2361 x 1568 pixels, CFP, FOV: 50 degrees:
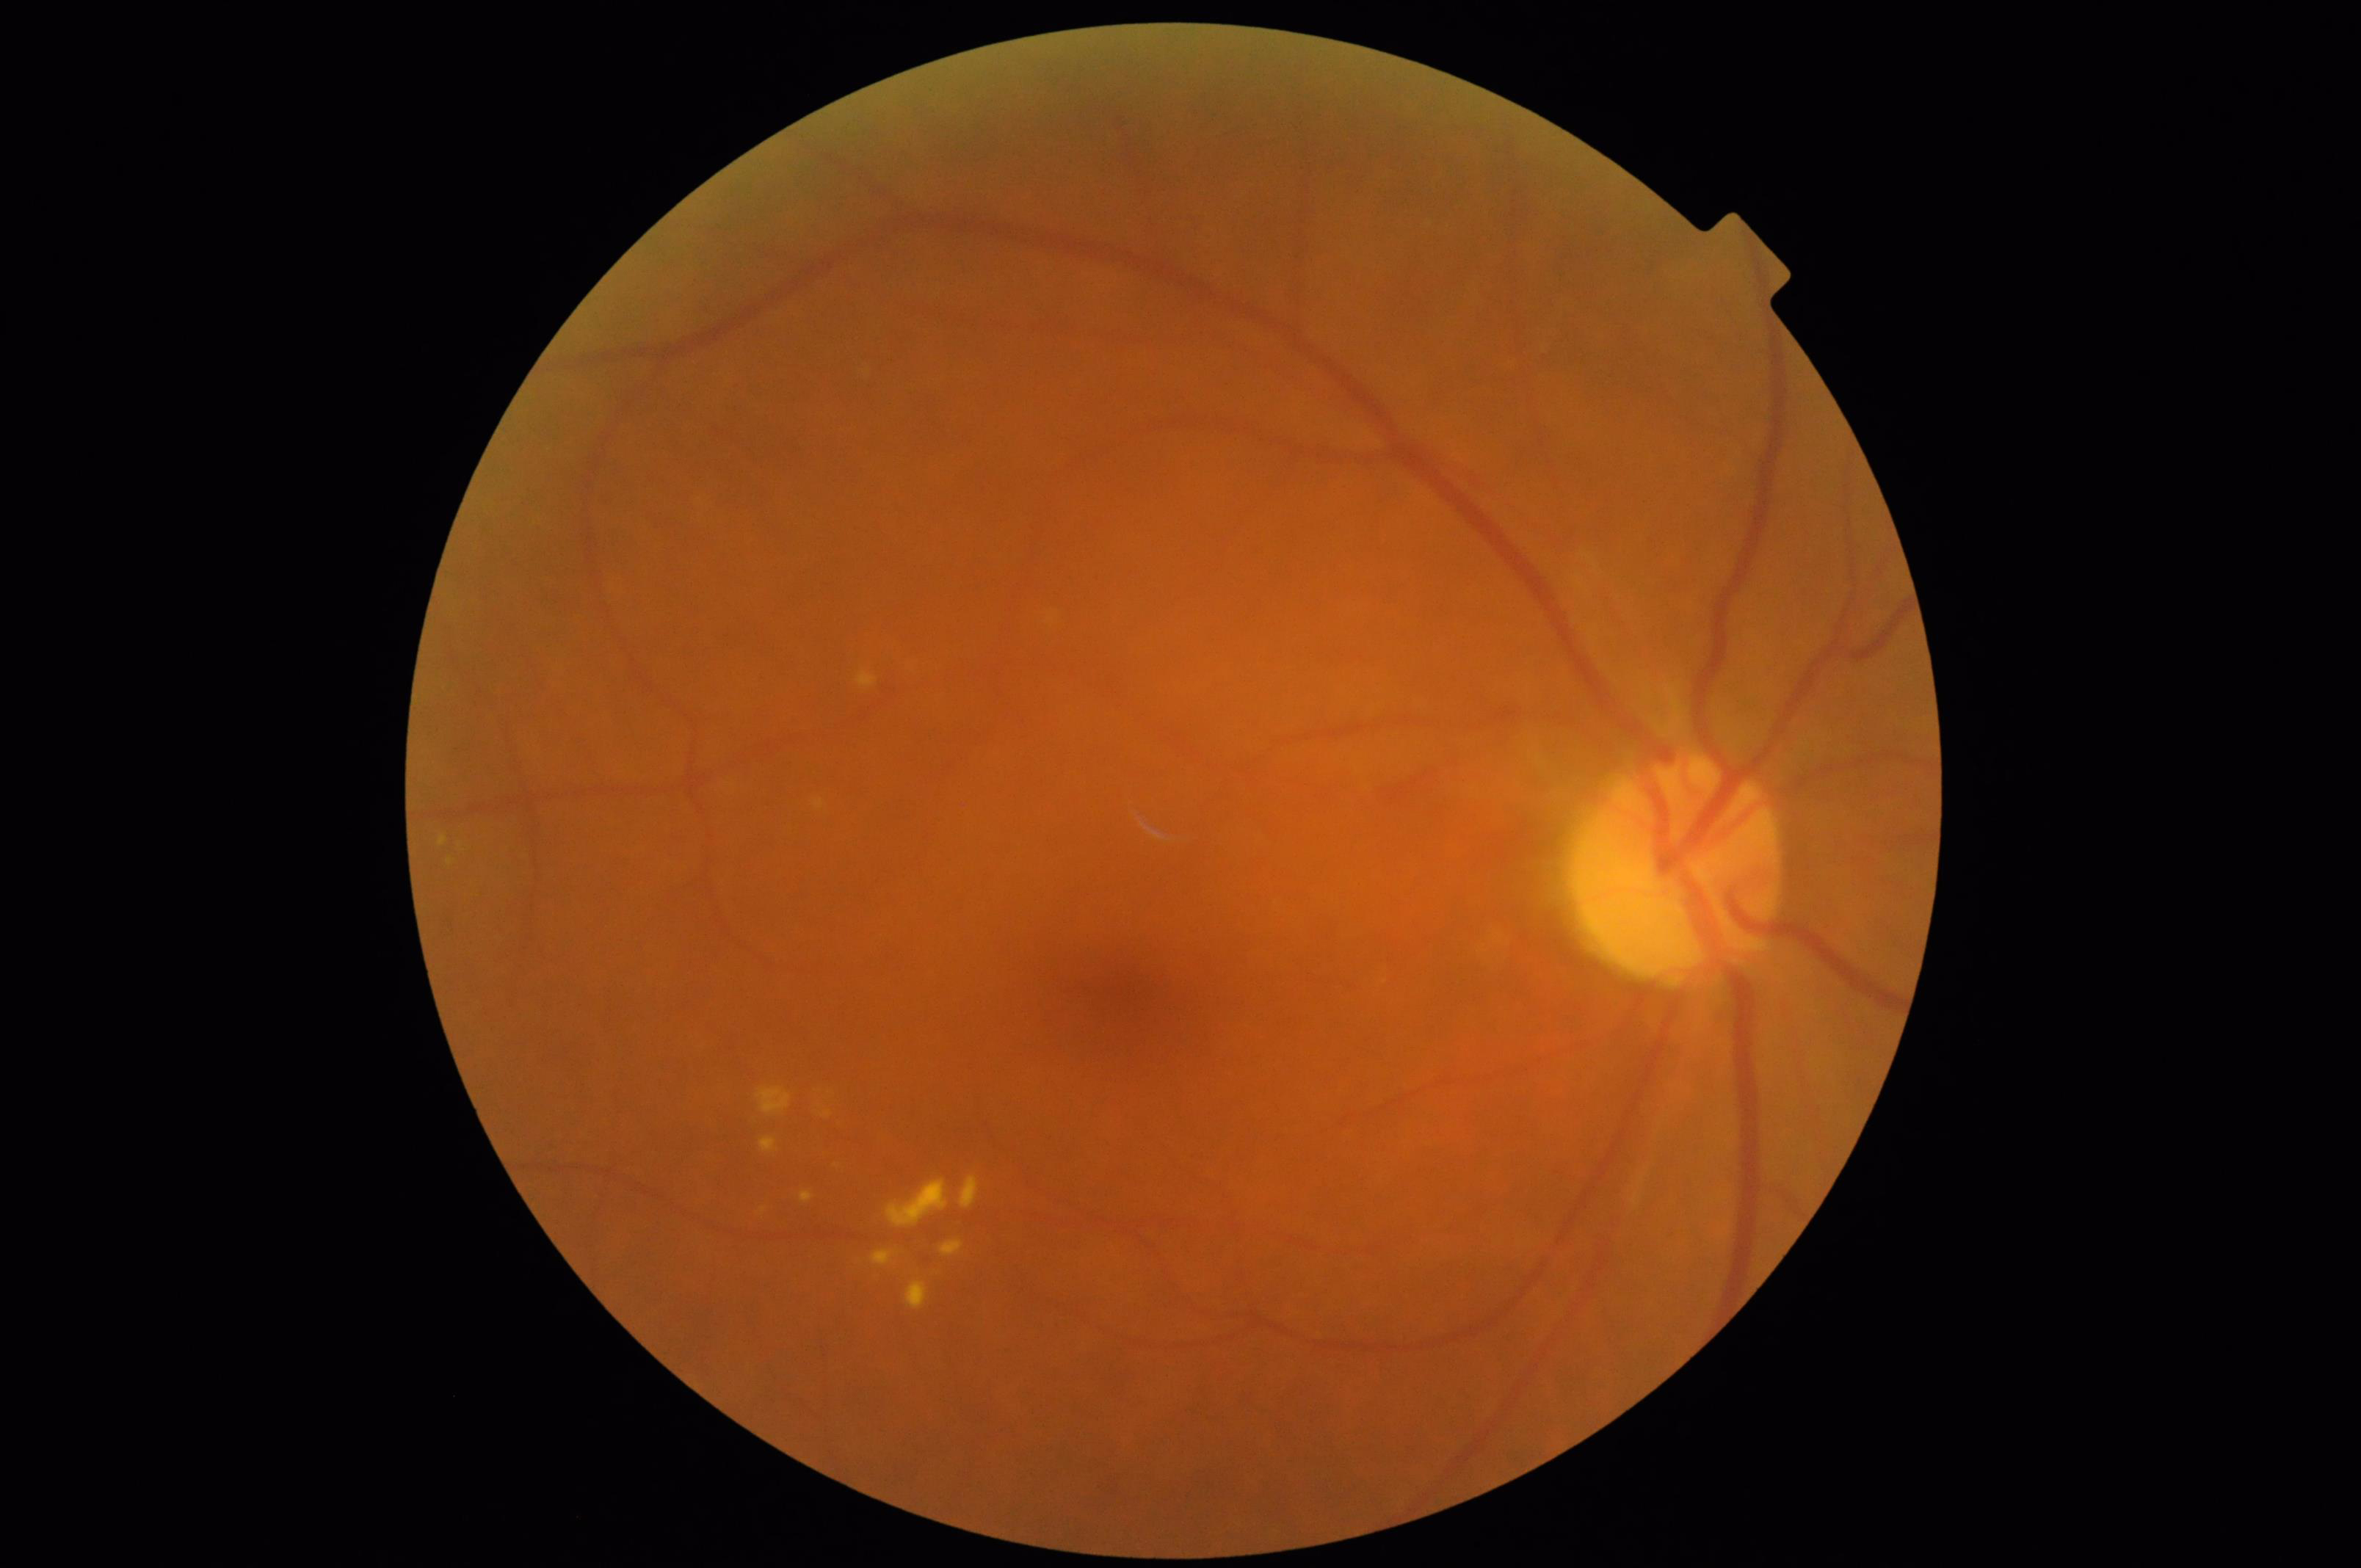

Sharpness: reduced; Overall: suboptimal; Illumination: good; Contrast: good.